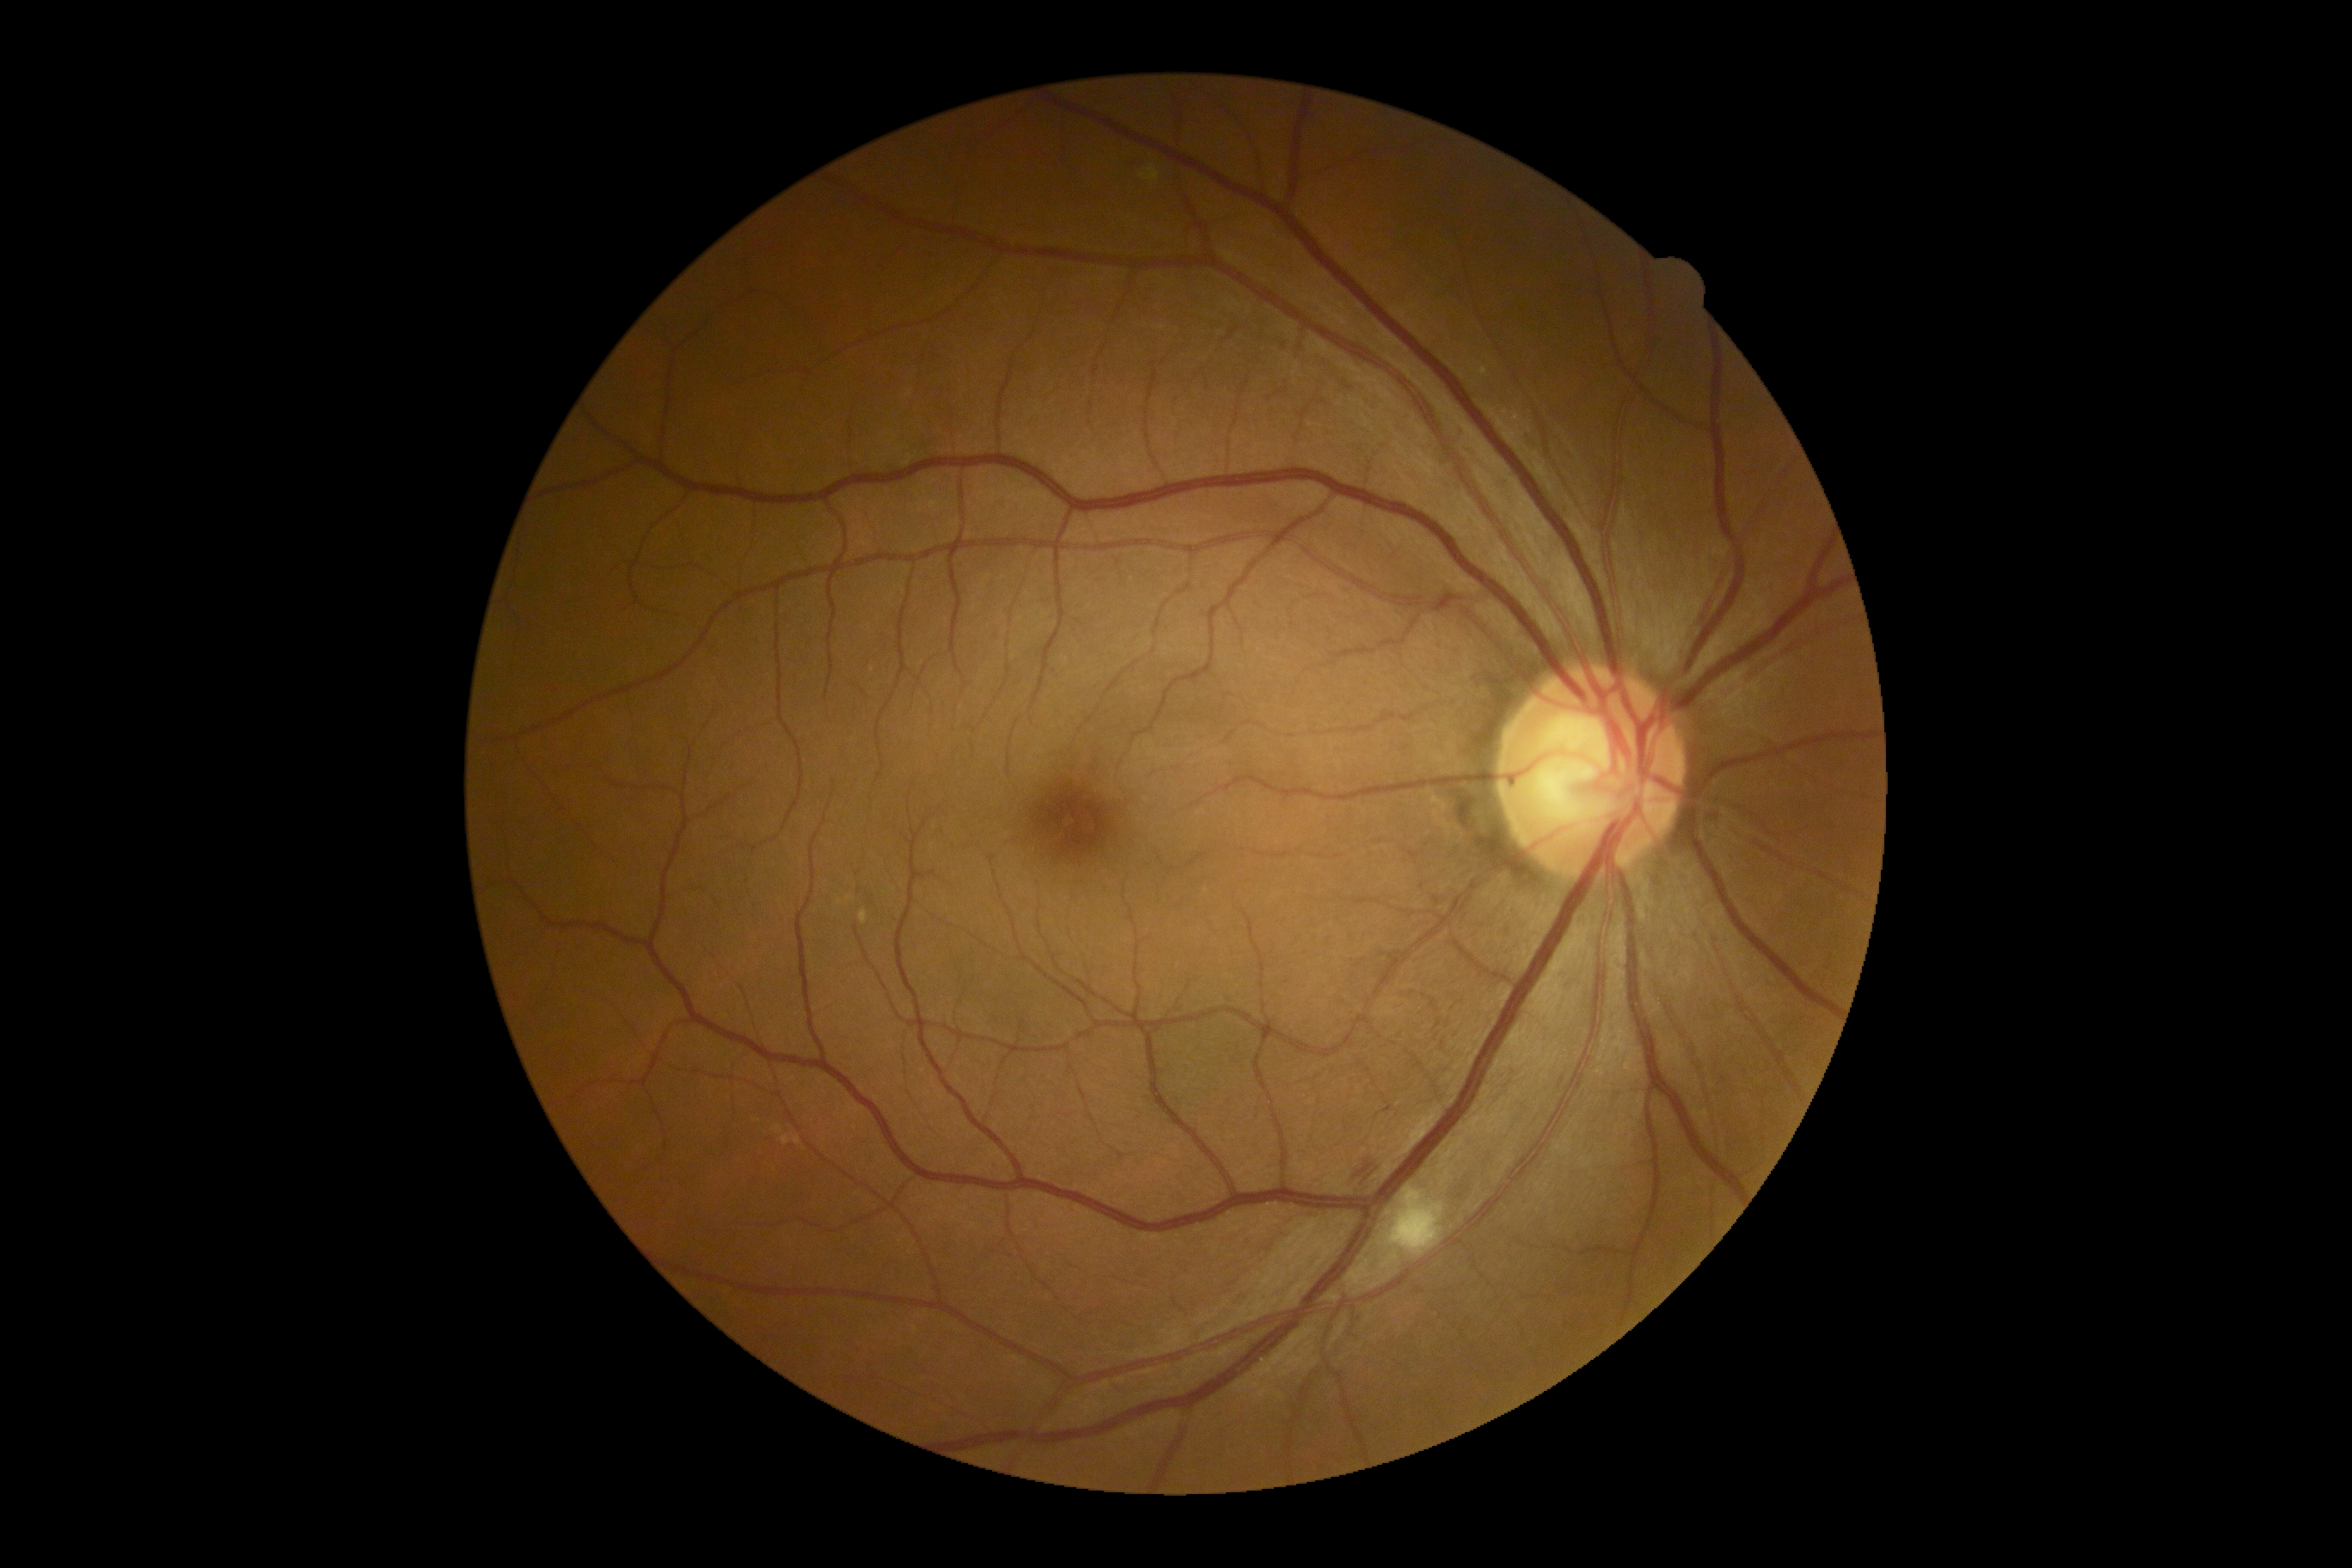
Annotations:
* DR: moderate NPDR (grade 2)